1932 x 1932 pixels.
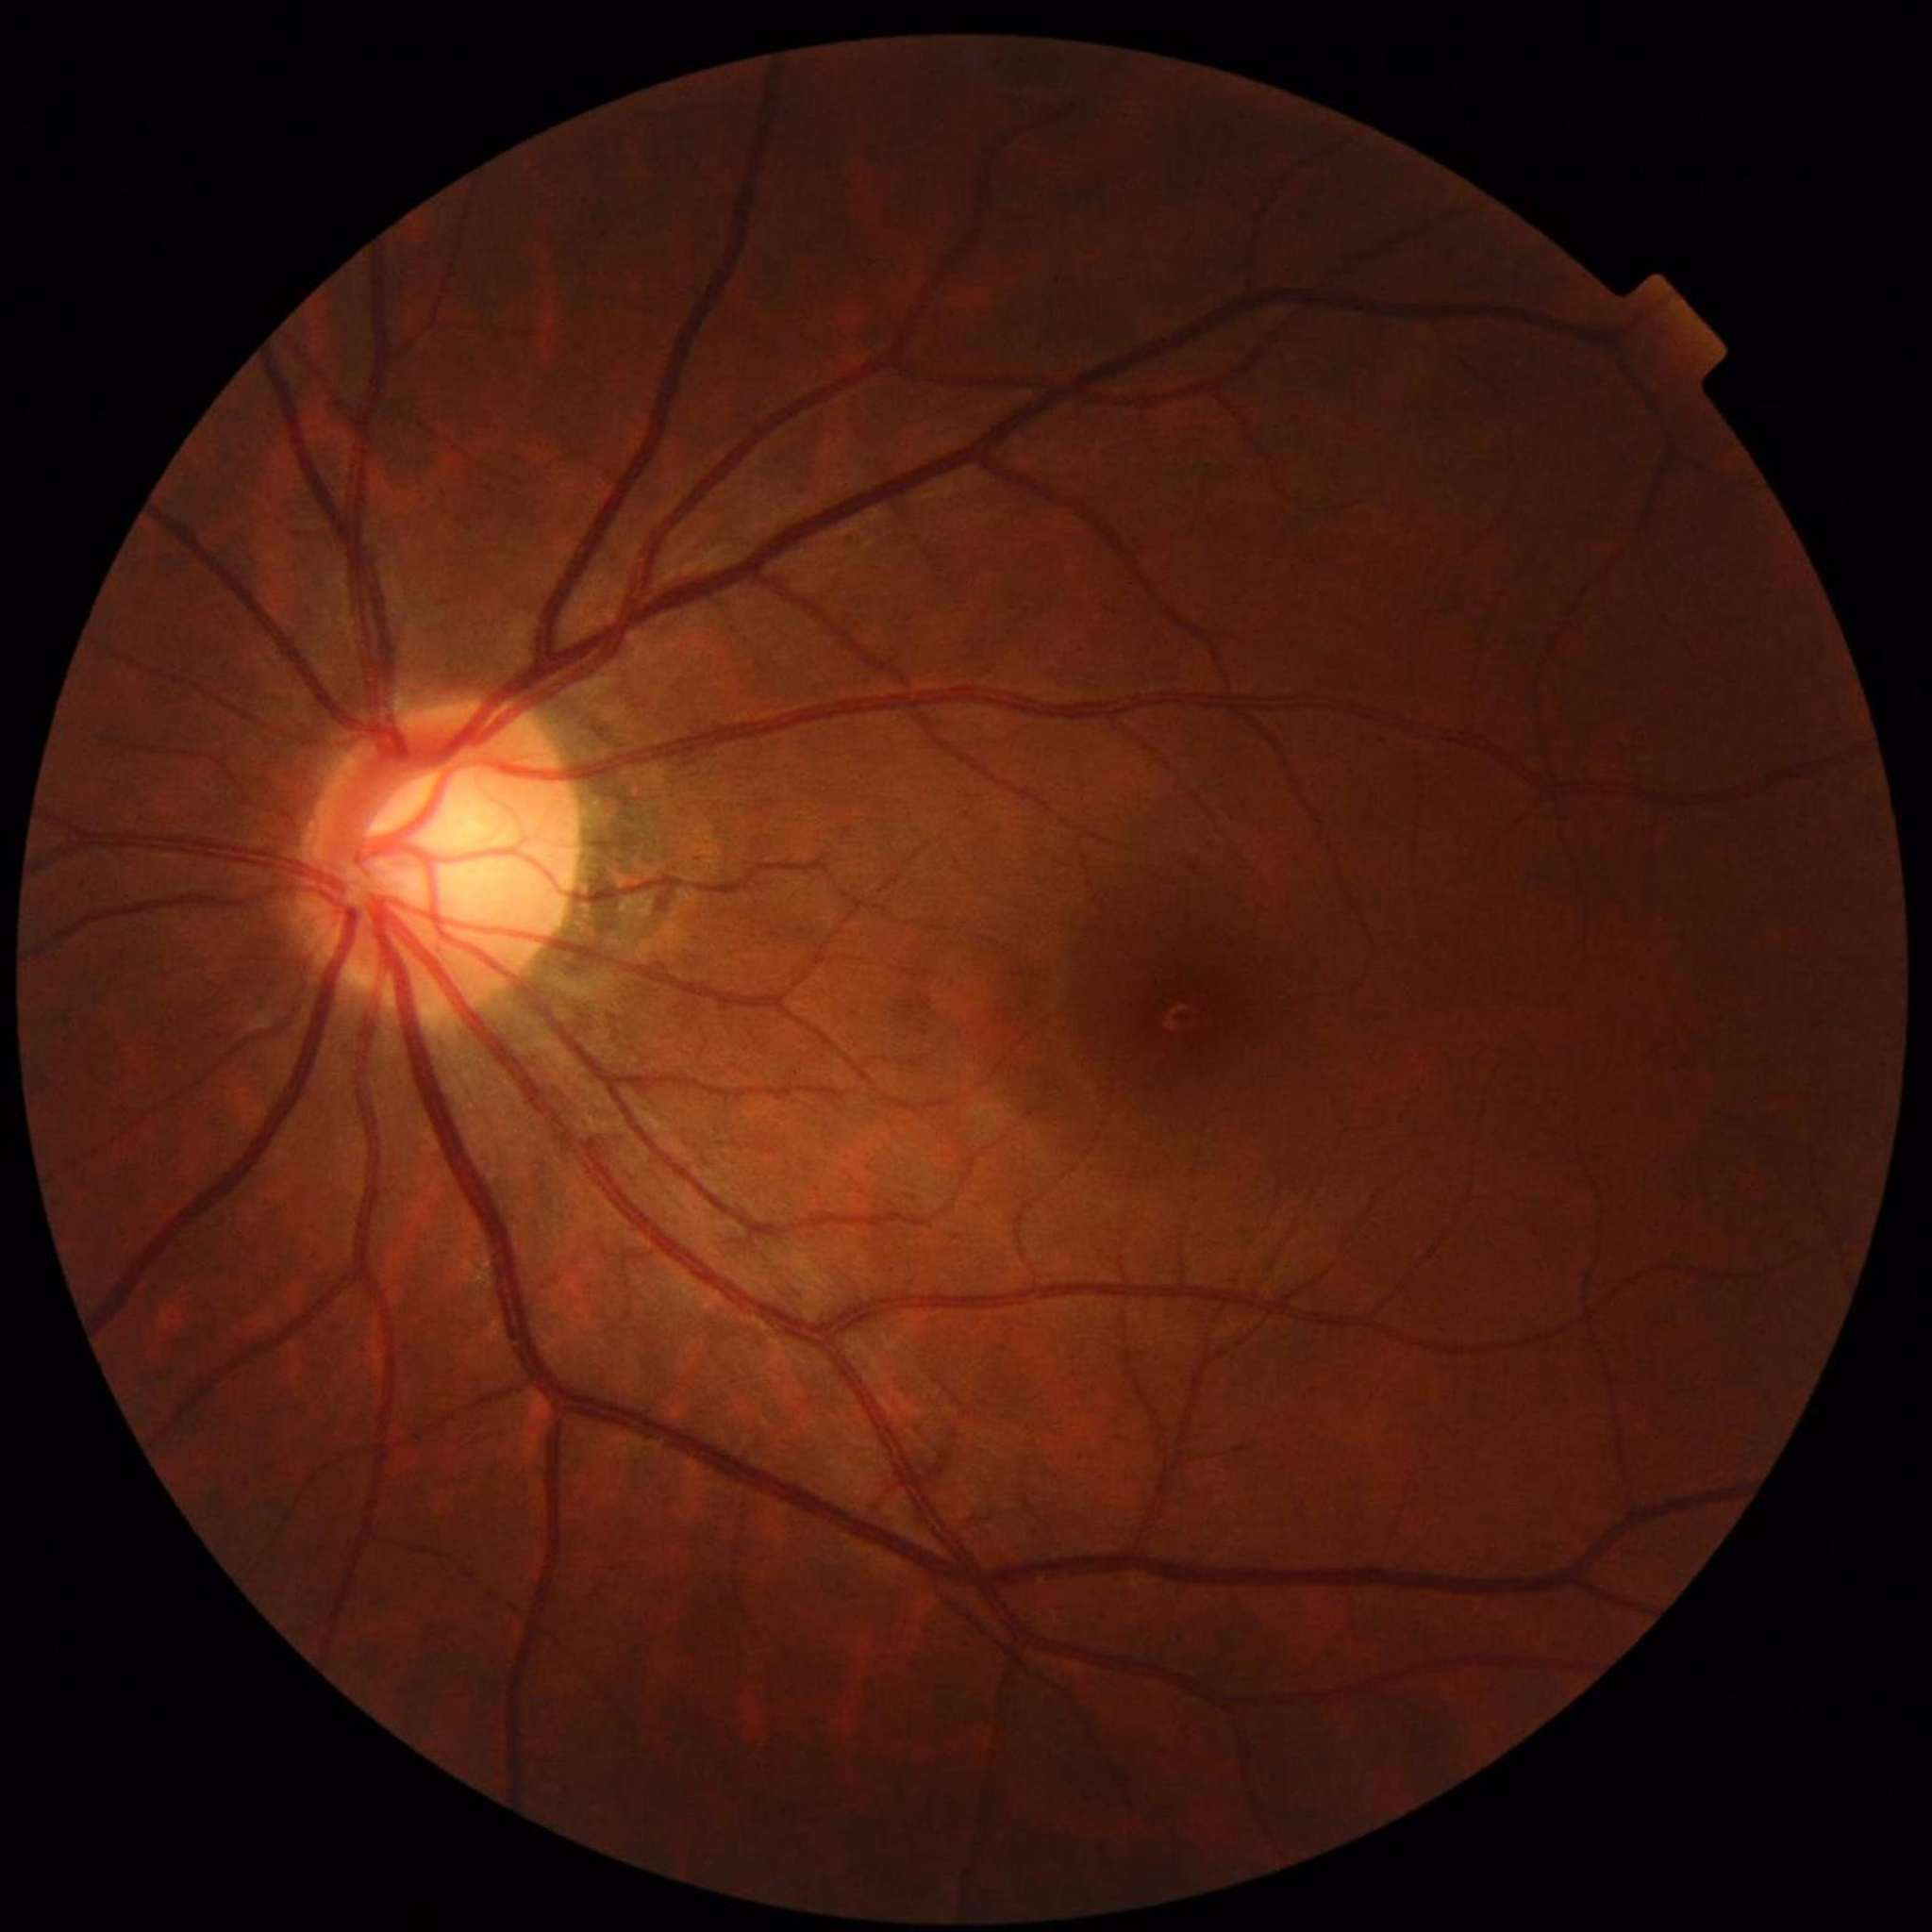 Color fundus photograph from a patient diagnosed with glaucoma.